45-degree field of view:
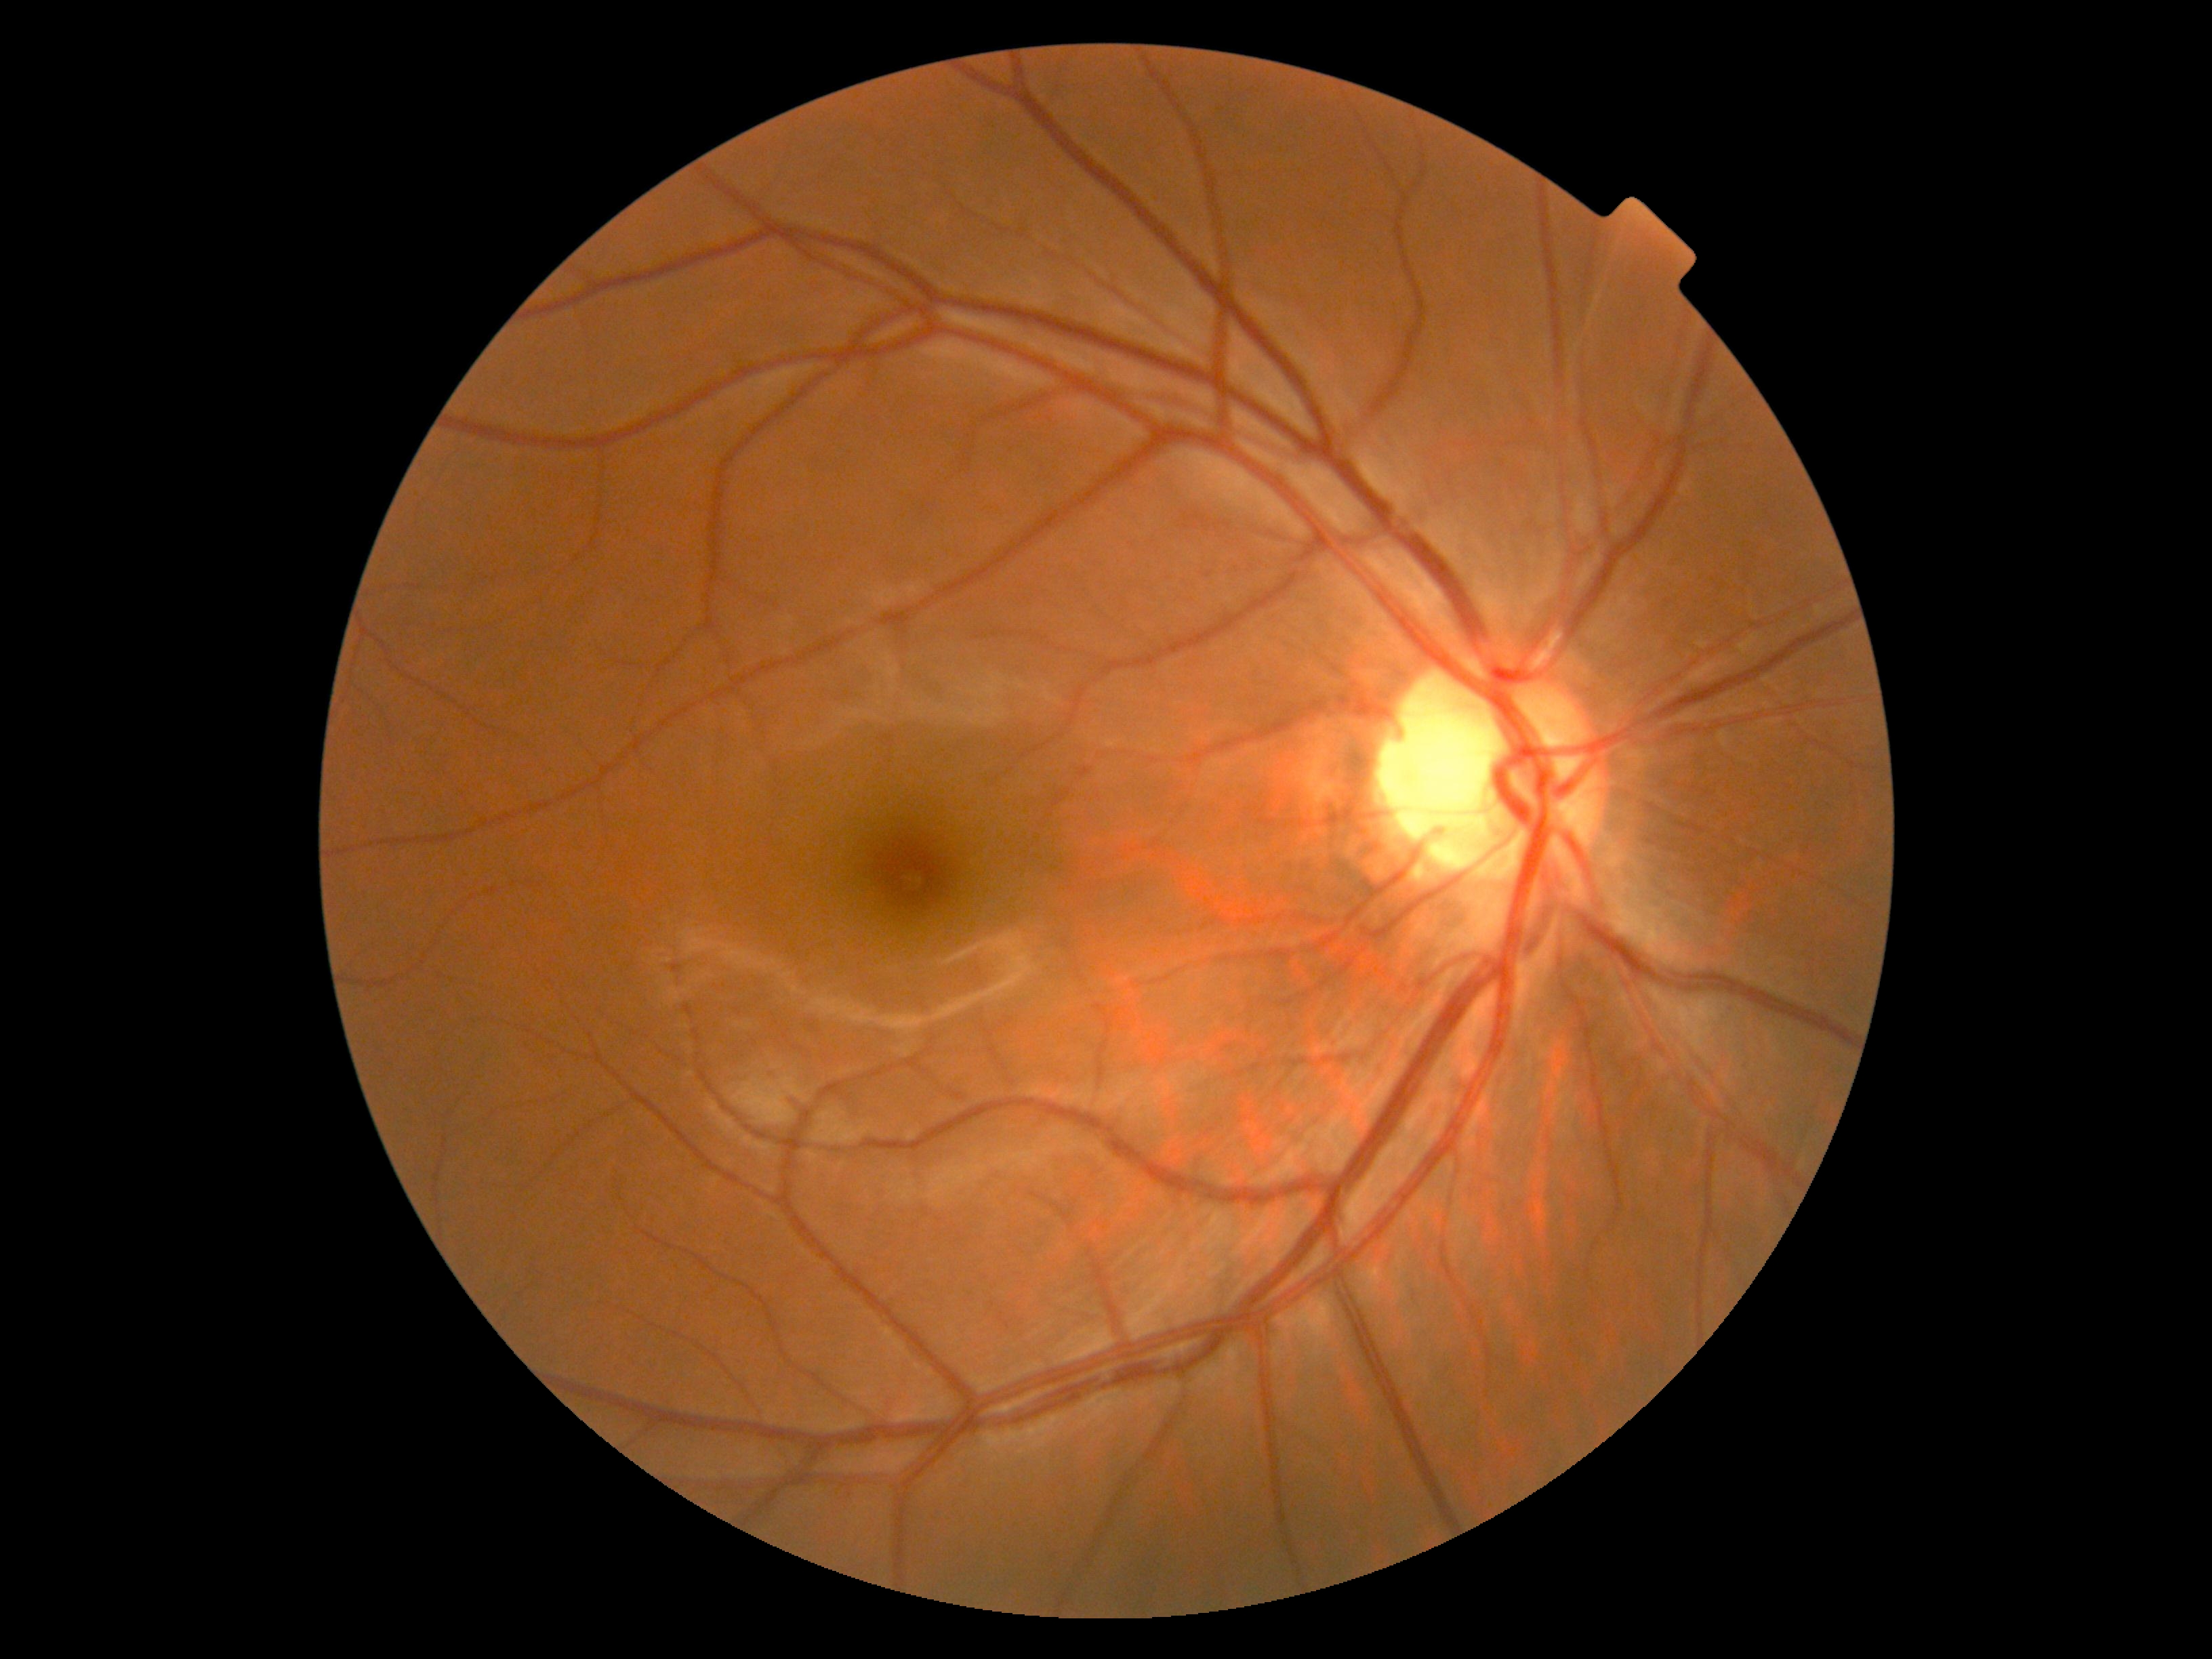
{"dr_grade": "grade 0 (no apparent retinopathy)"}